Centered on the optic disc
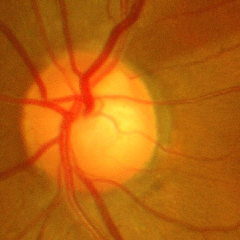
Glaucoma status: advanced-stage glaucoma.